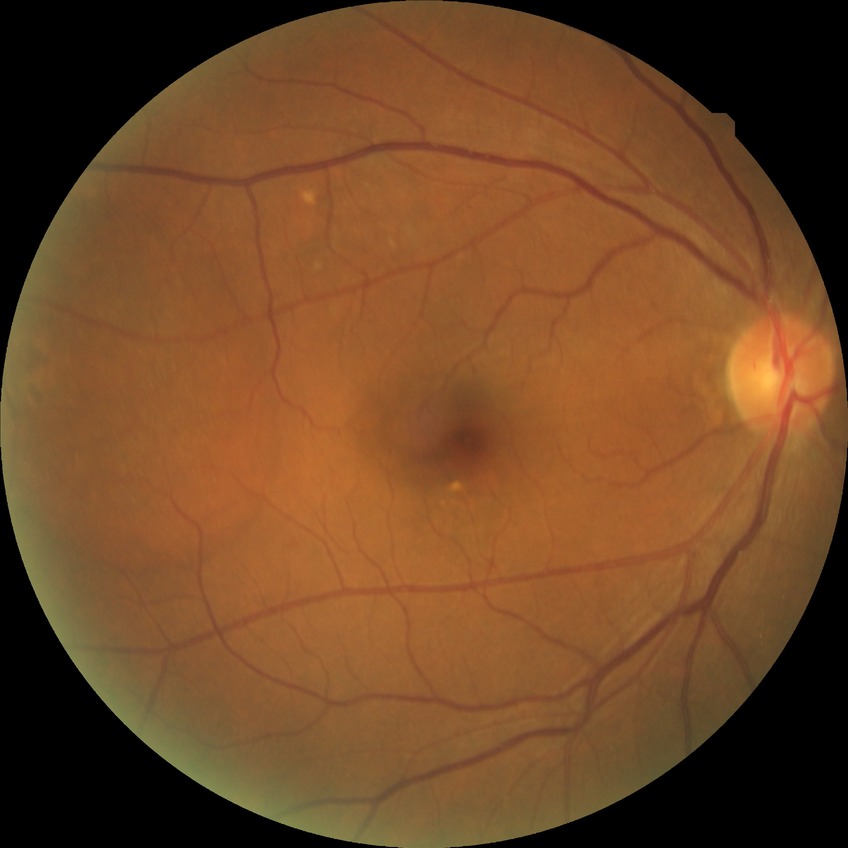 Davis grading is no diabetic retinopathy.